1440x1080px · wide-field fundus photograph from neonatal ROP screening.
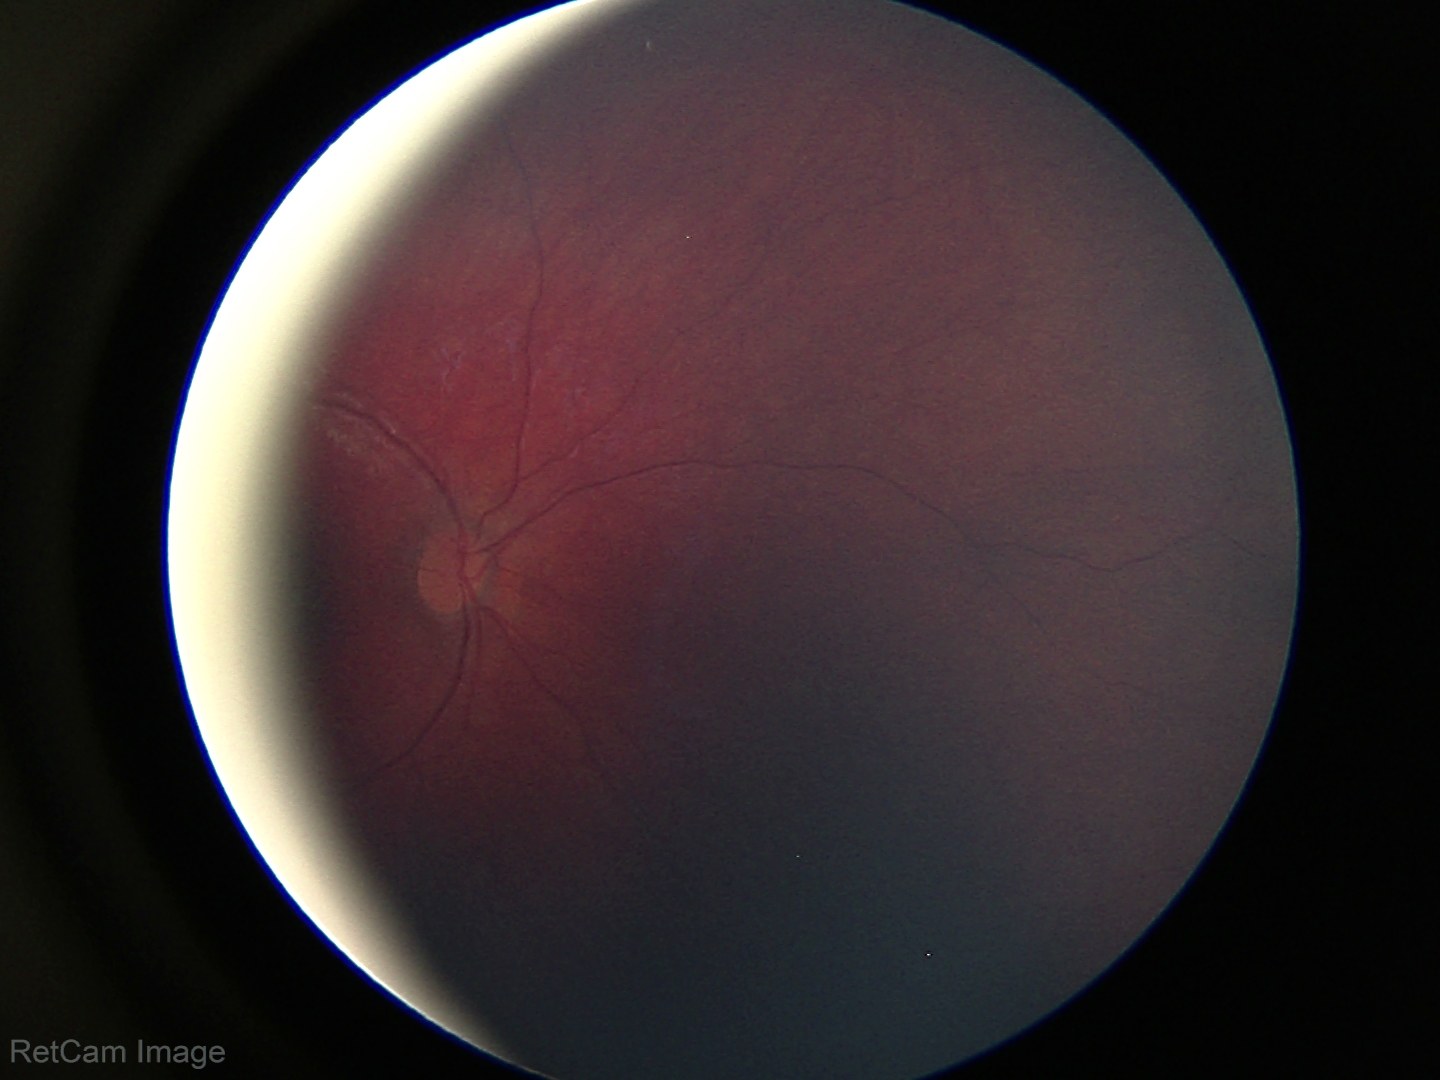

Screening: physiological finding.